Pediatric wide-field fundus photograph:
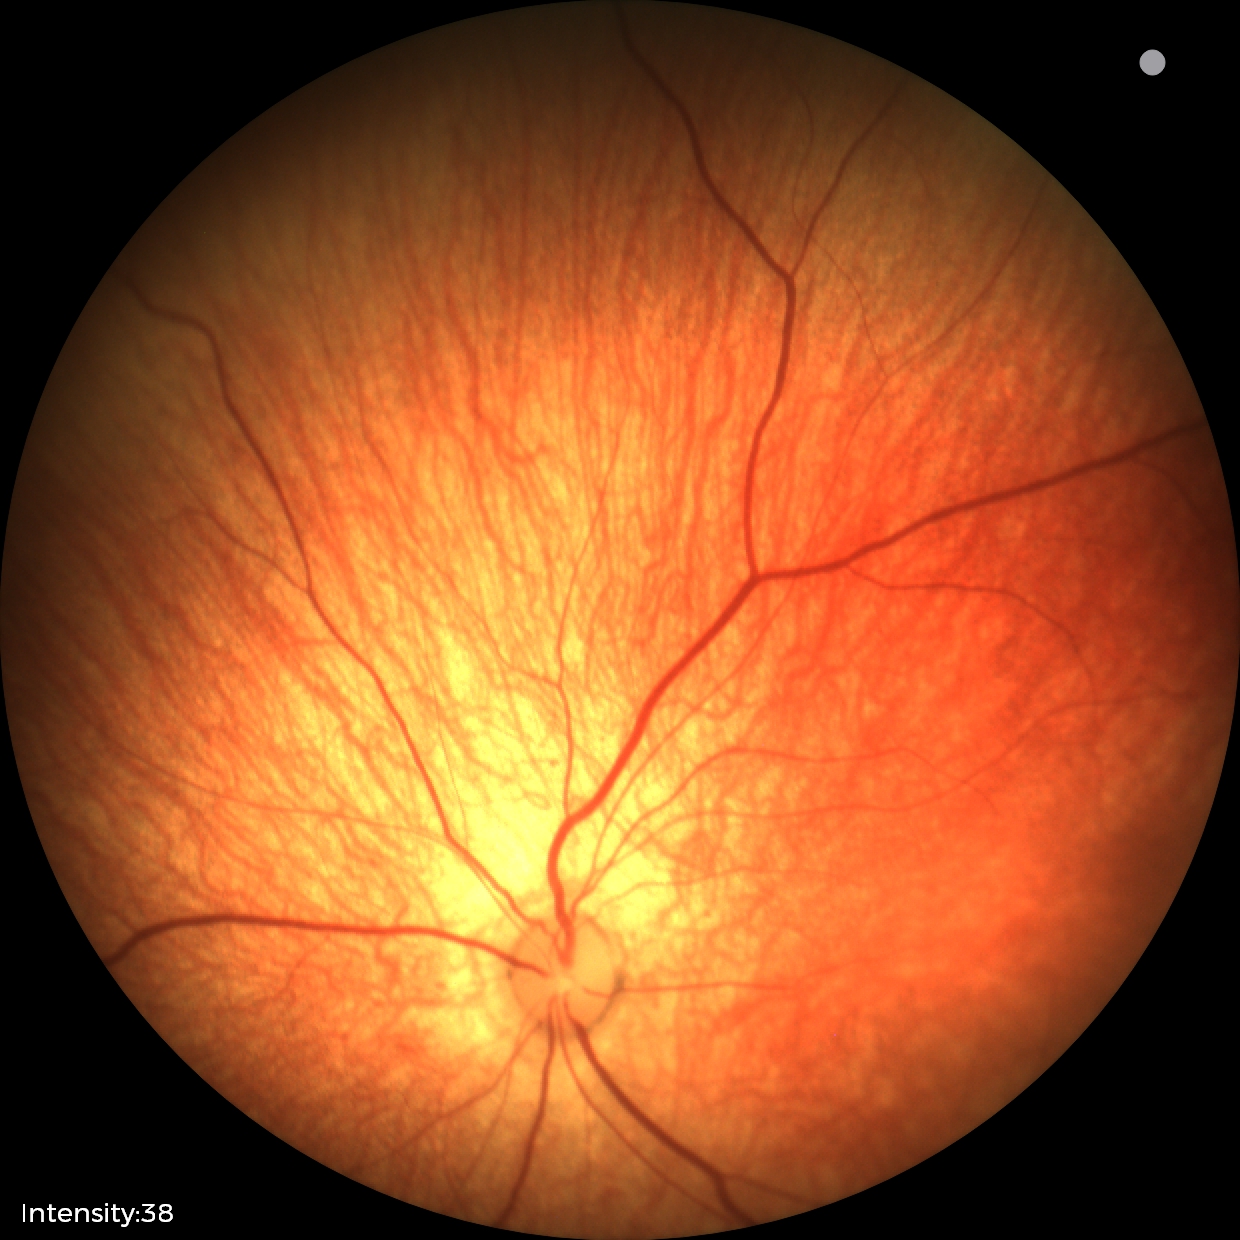

Impression: normal